Optic disc photograph. Acquired with a Topcon TRC
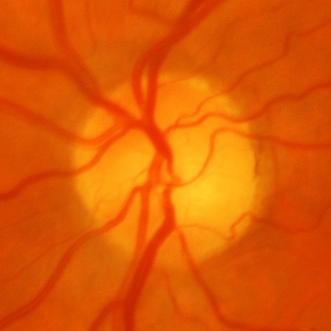
Glaucoma assessment = glaucomatous optic neuropathy.